1932x1910, color fundus image — 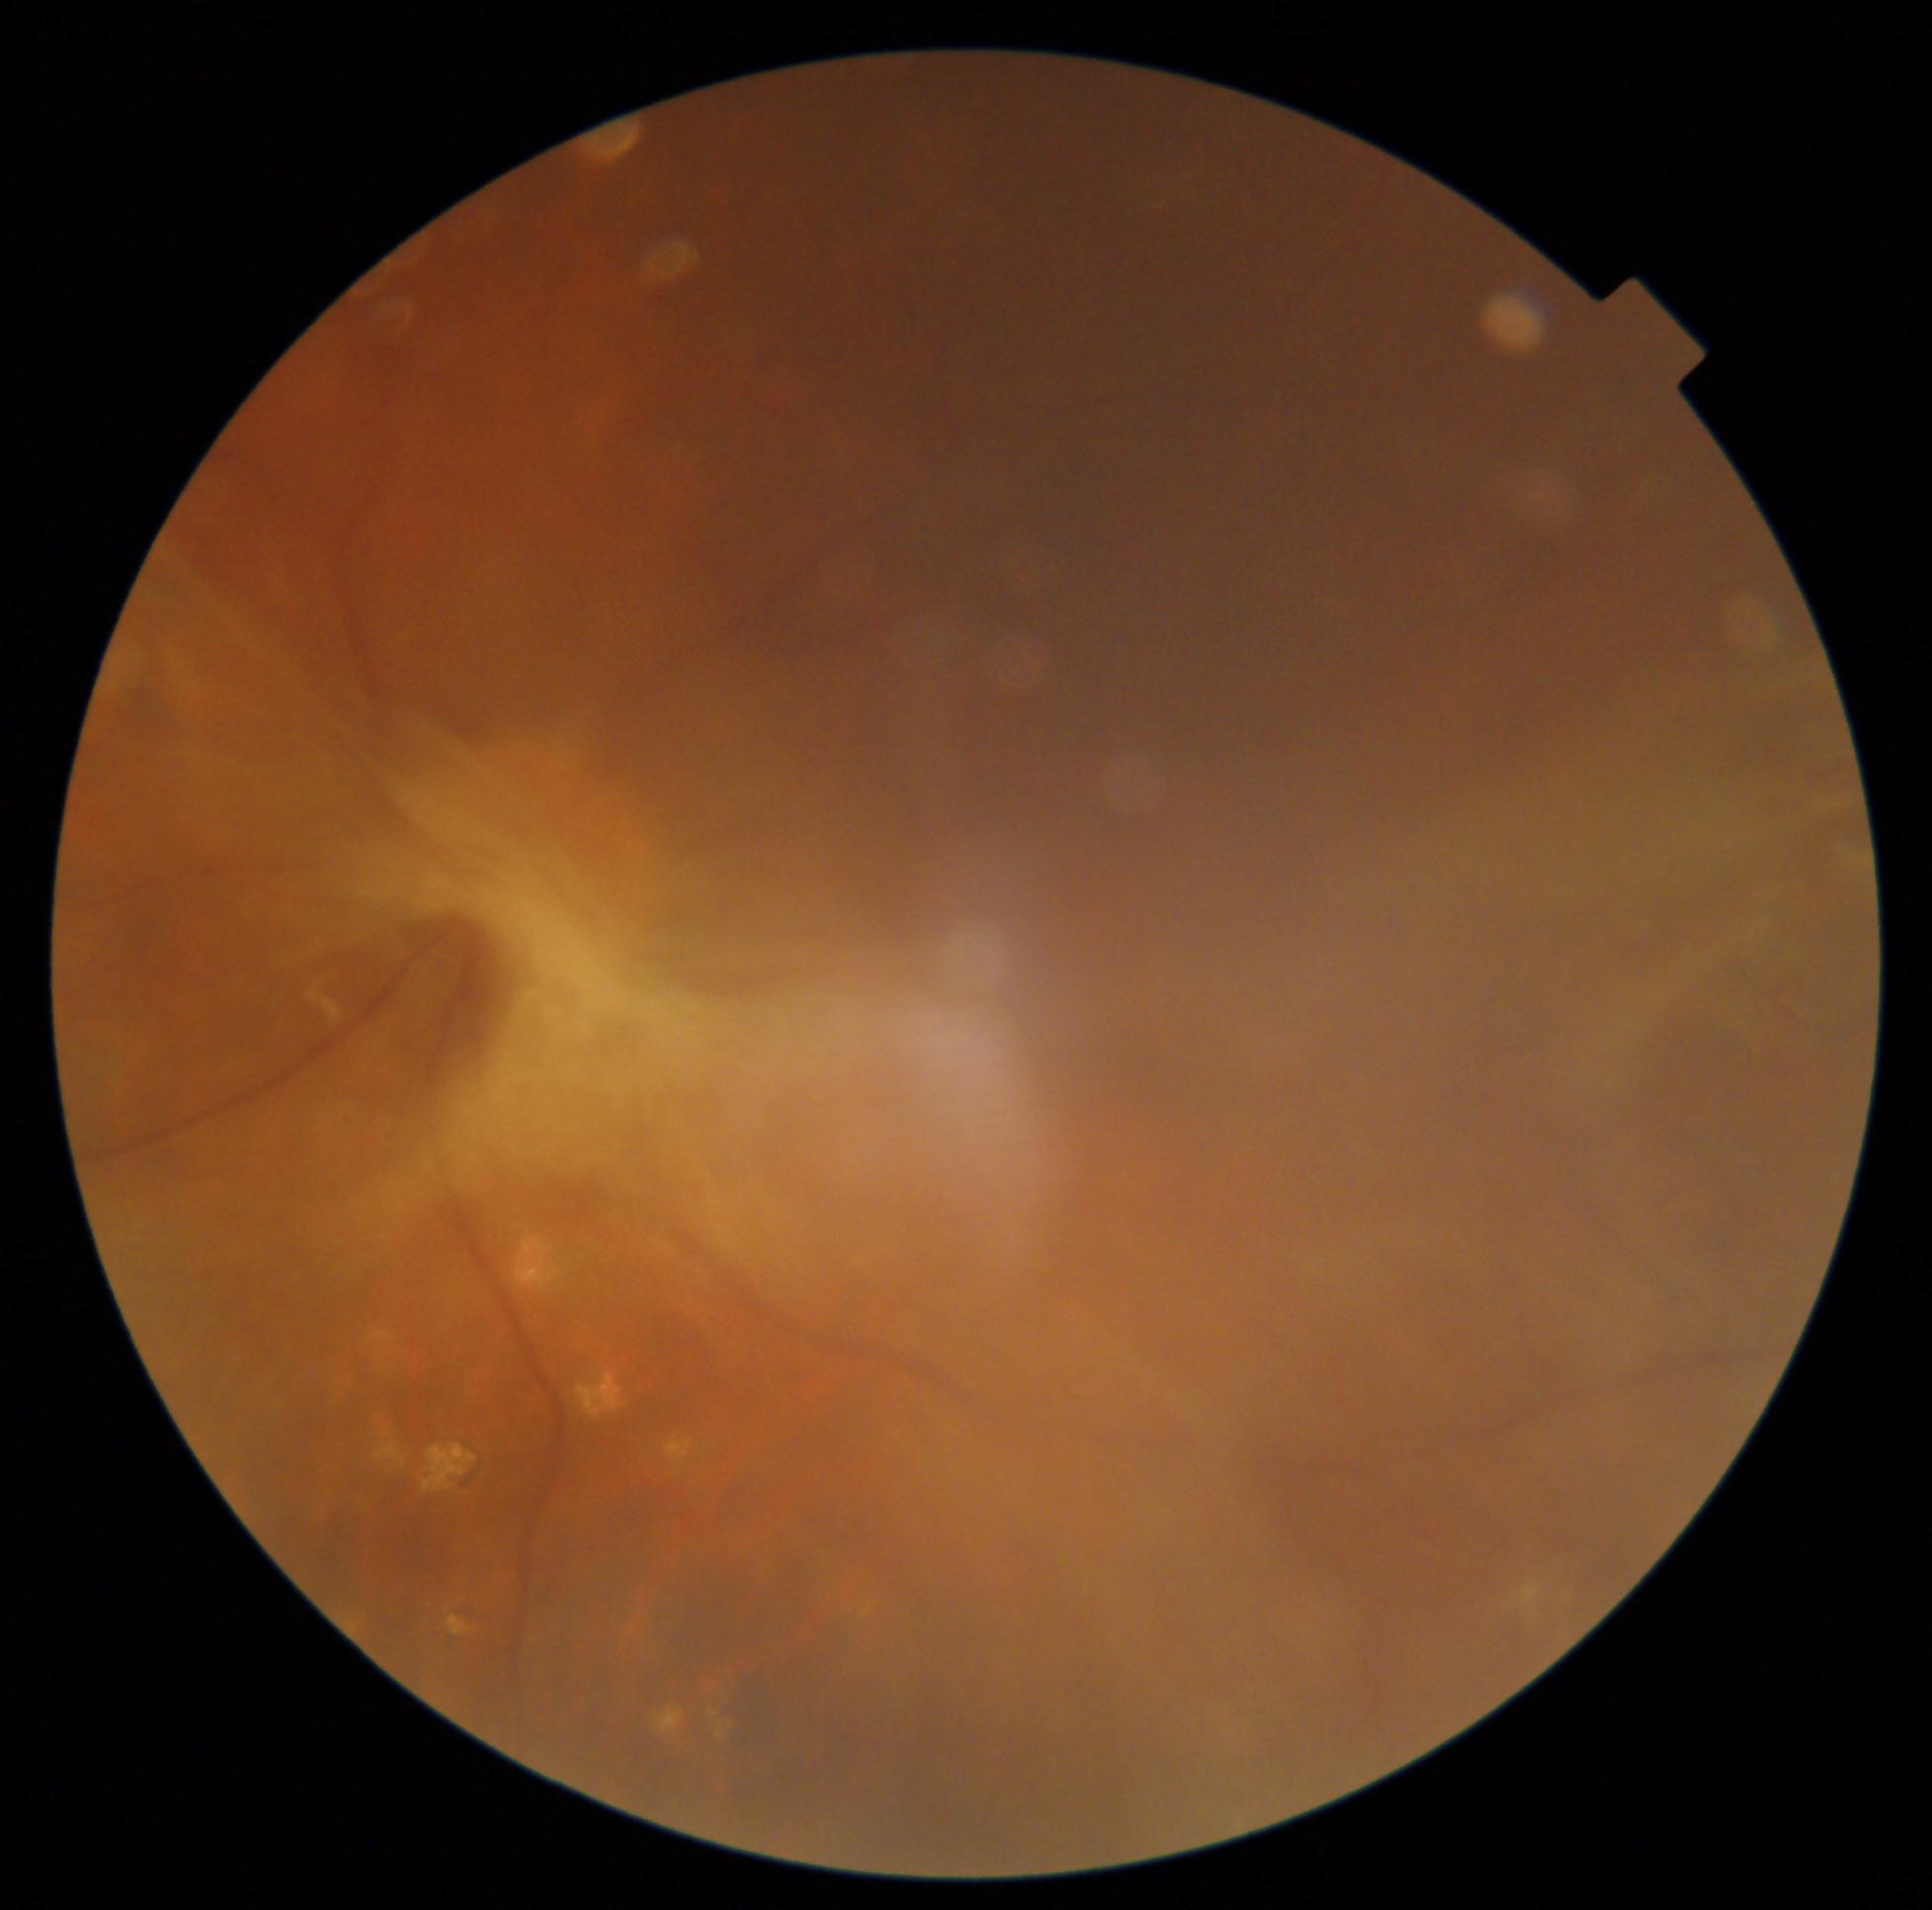
Retinopathy grade: 4 (PDR). The retinopathy is classified as proliferative diabetic retinopathy.